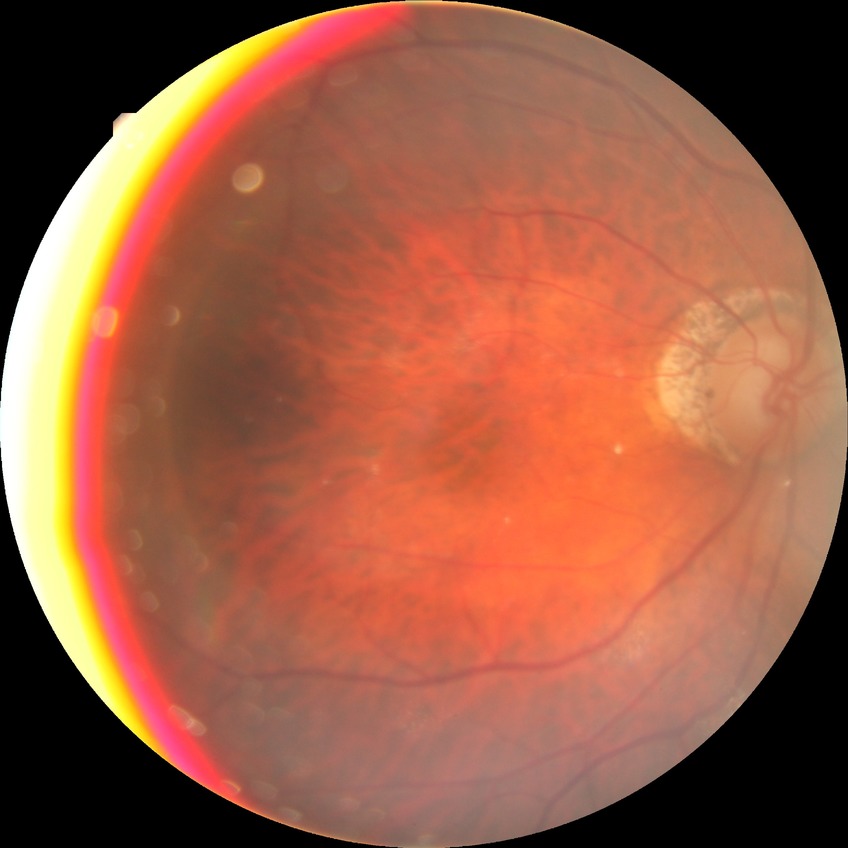

Diabetic retinopathy (DR) is NDR (no diabetic retinopathy).